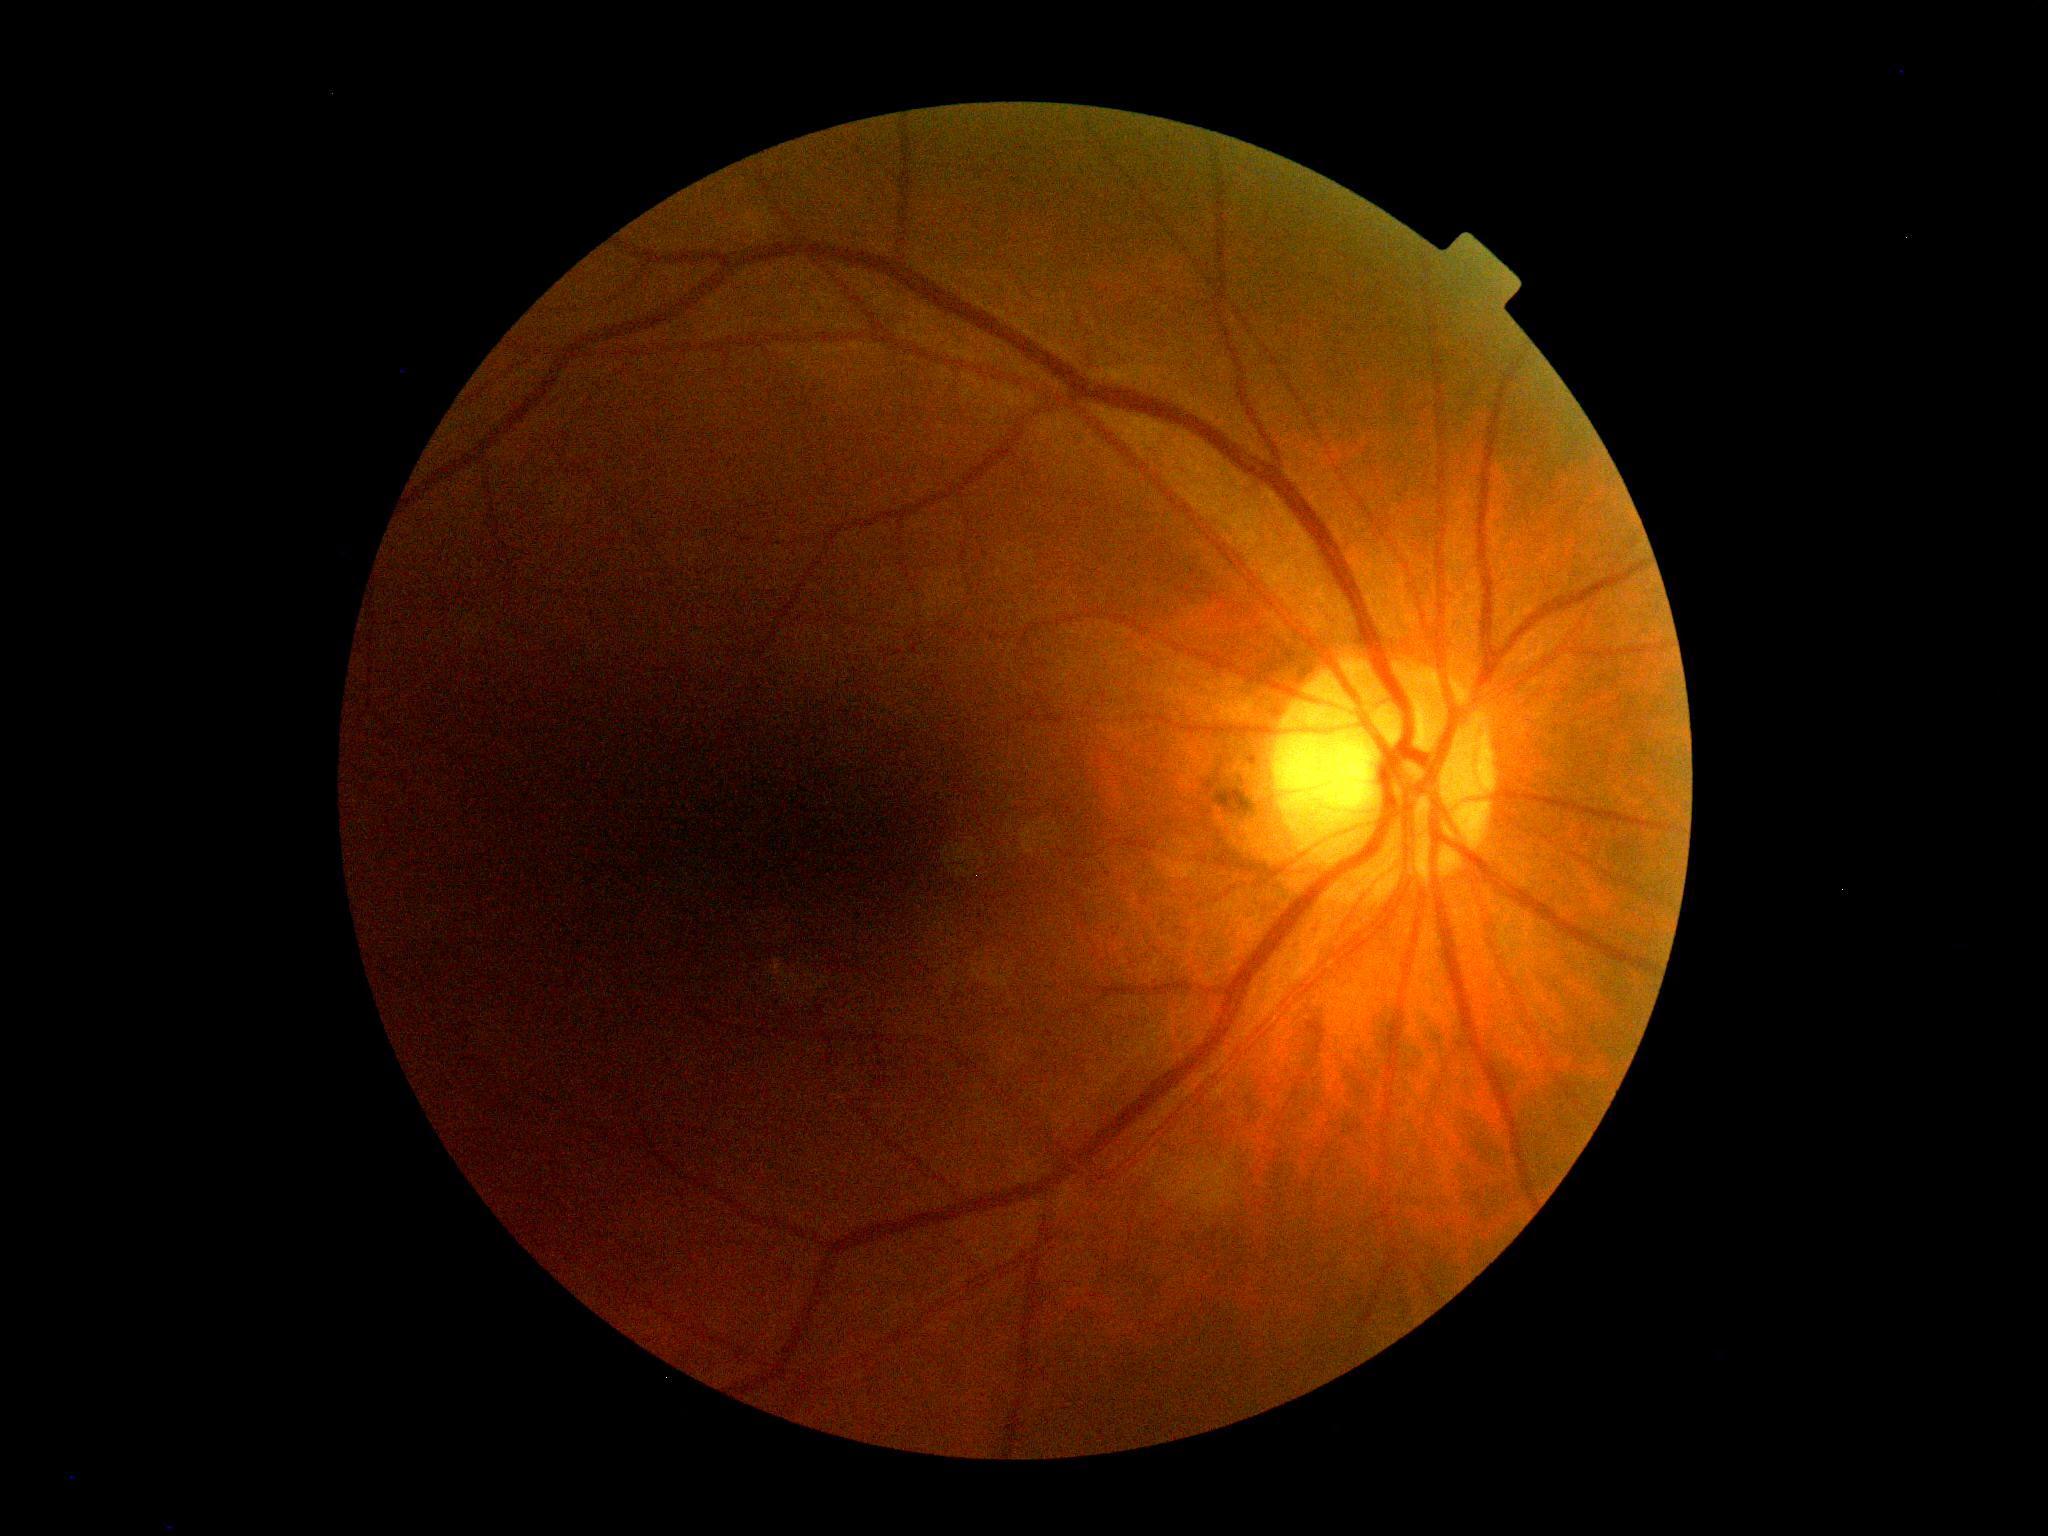
{
  "dr_grade": "0 (no apparent retinopathy)"
}